CFP. 1932 by 1932 pixels: 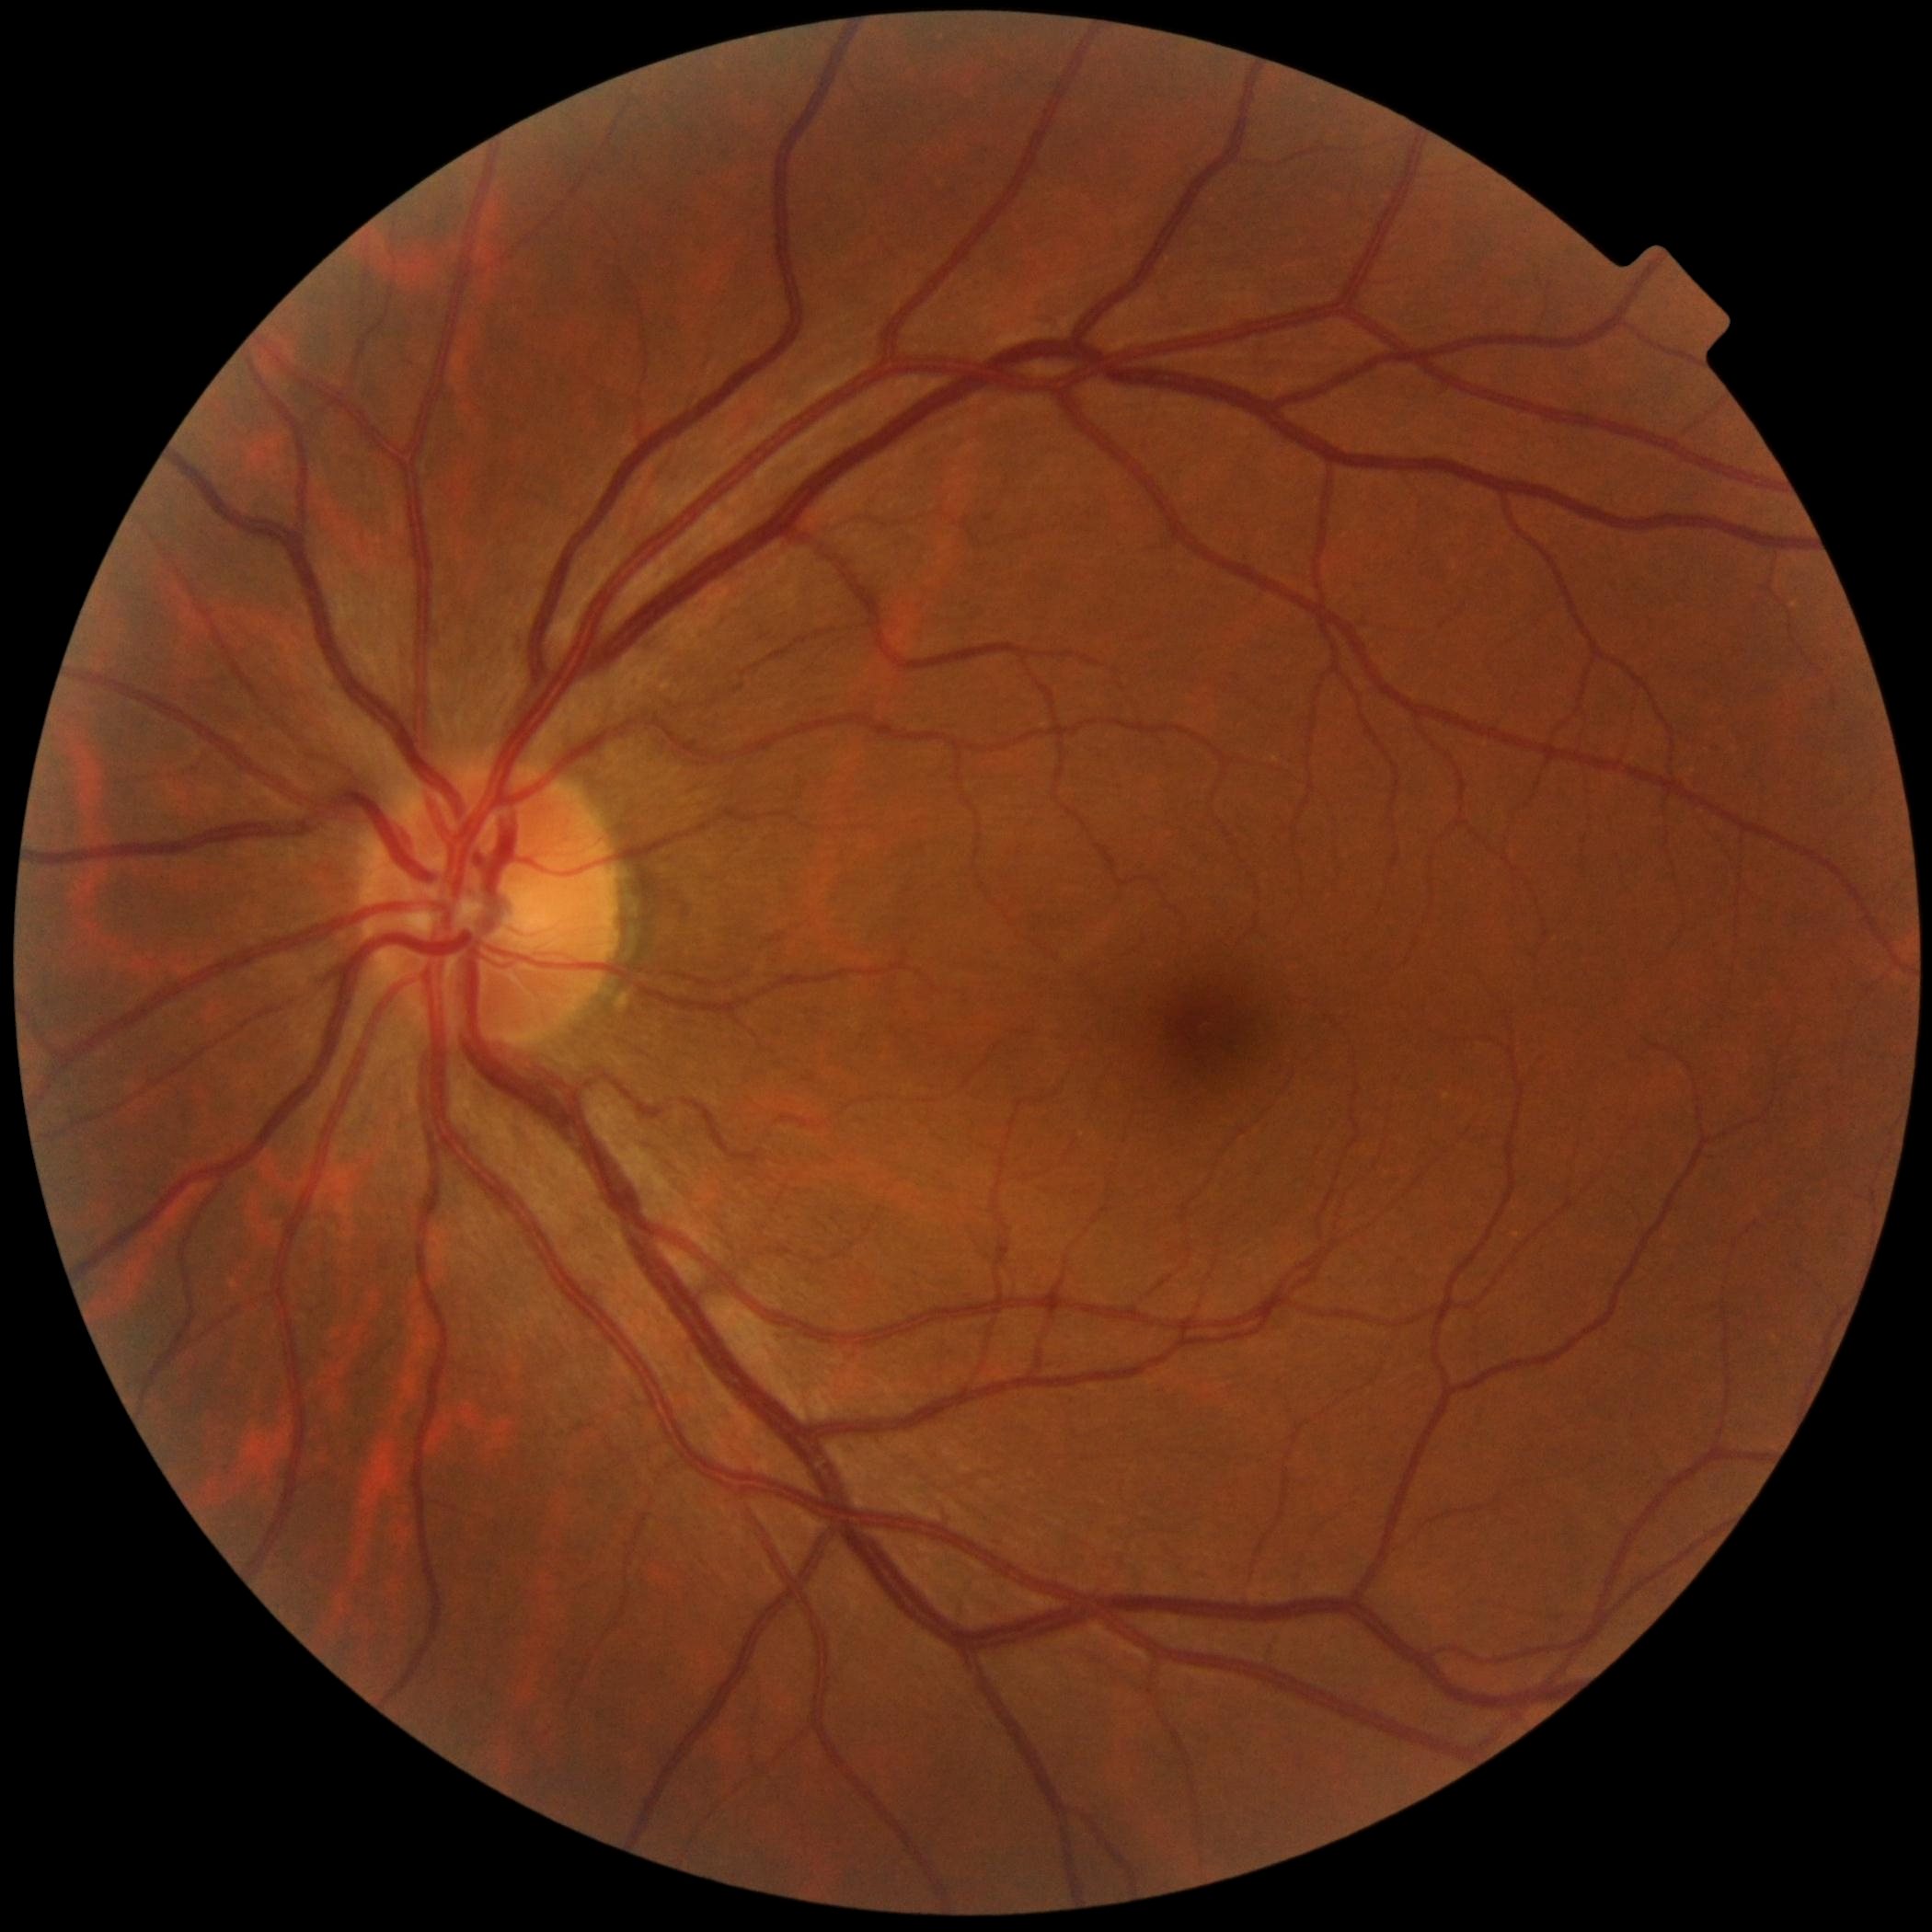
Diabetic retinopathy (DR): no apparent diabetic retinopathy (grade 0).